Diabetic retinopathy graded by the modified Davis classification
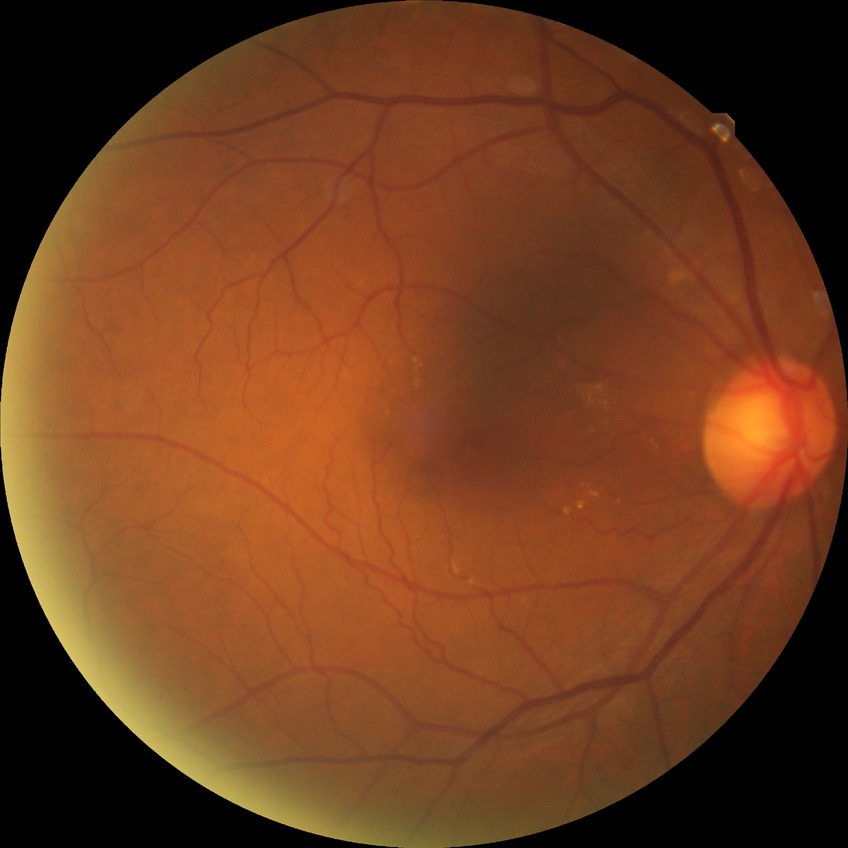 Retinopathy grade: simple diabetic retinopathy.